Wide-field fundus image from infant ROP screening — 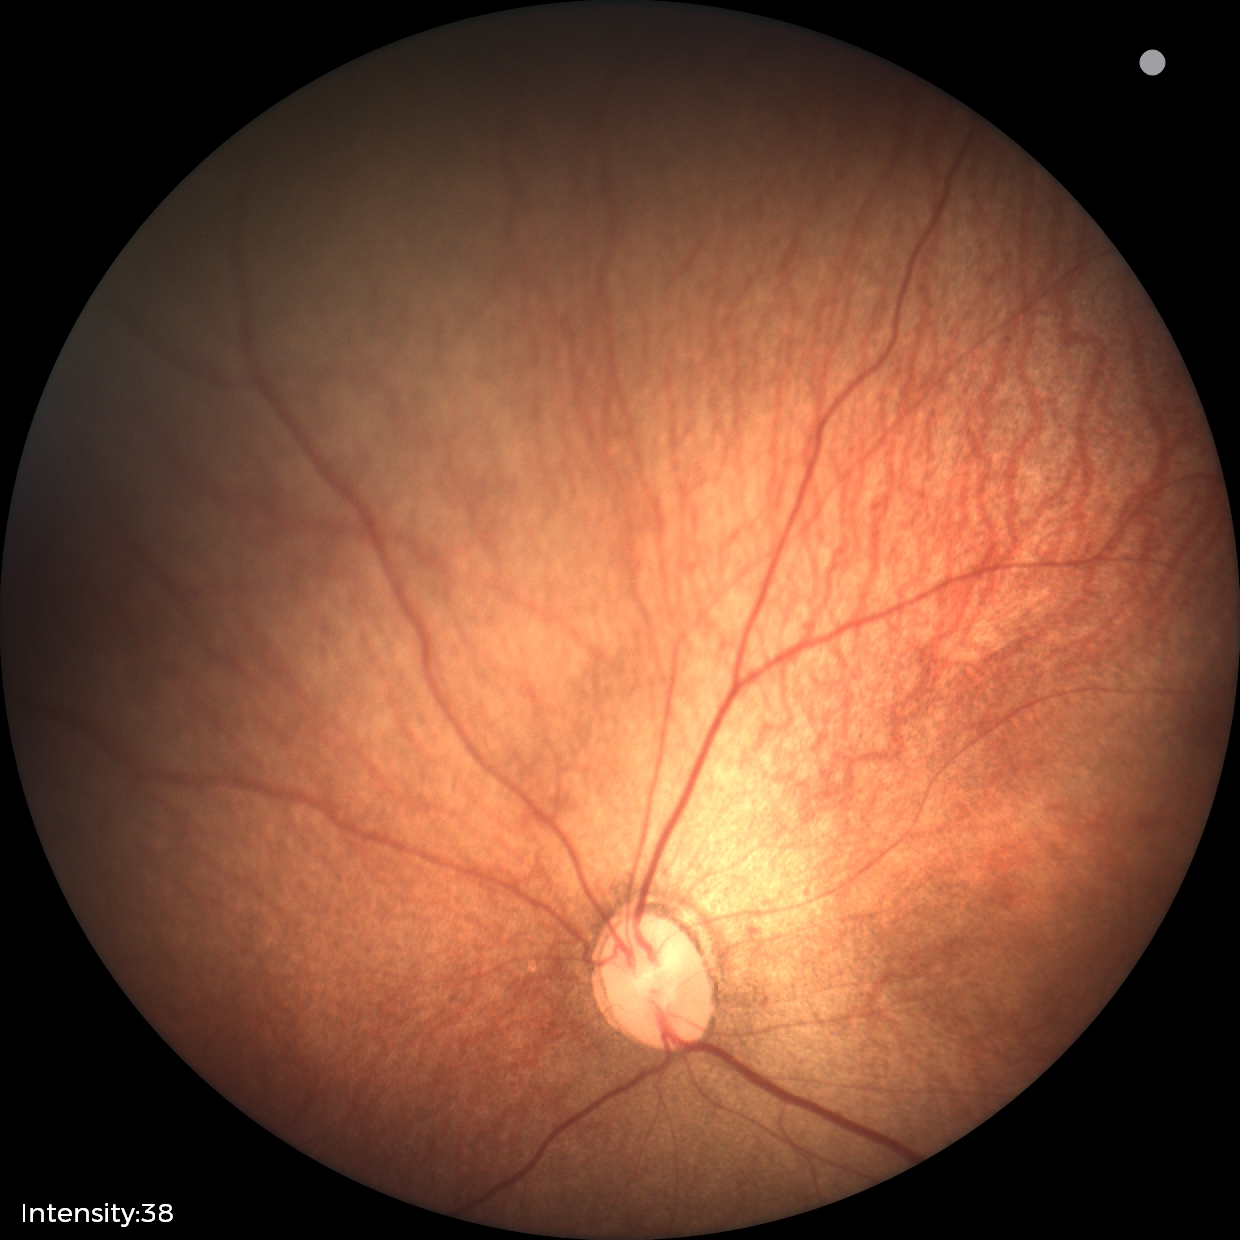
Plus disease = absent | screening diagnosis = status post retinopathy of prematurity (ROP).